Phoenix ICON wide-field infant fundus image
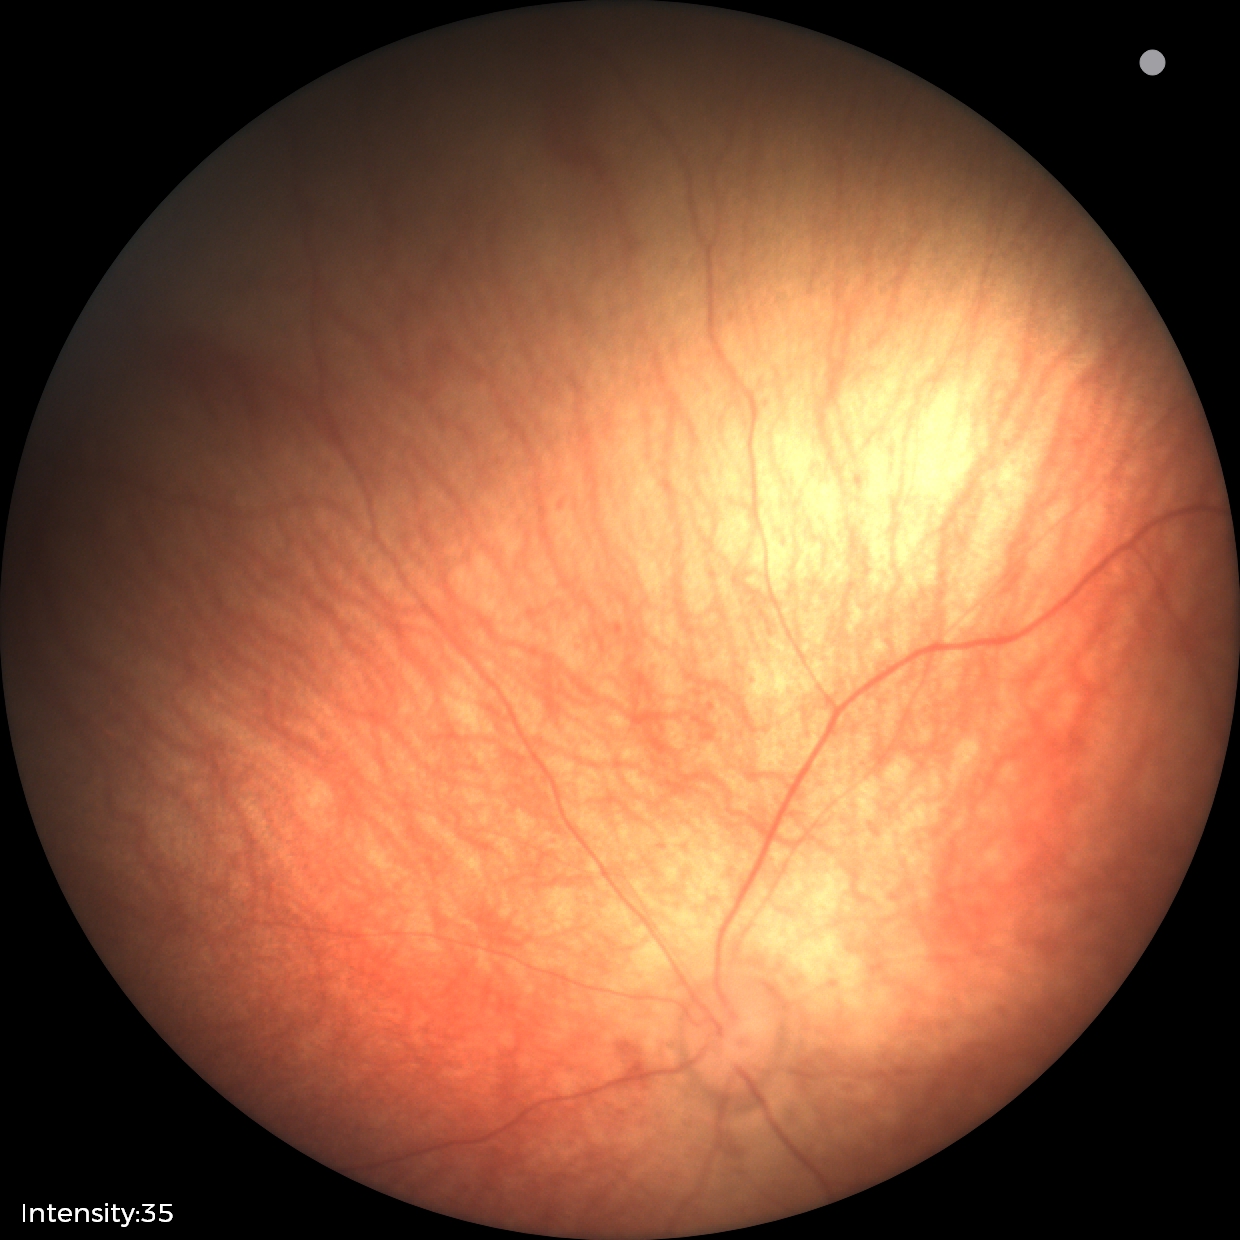

Examination with physiological retinal findings.